45-degree field of view: 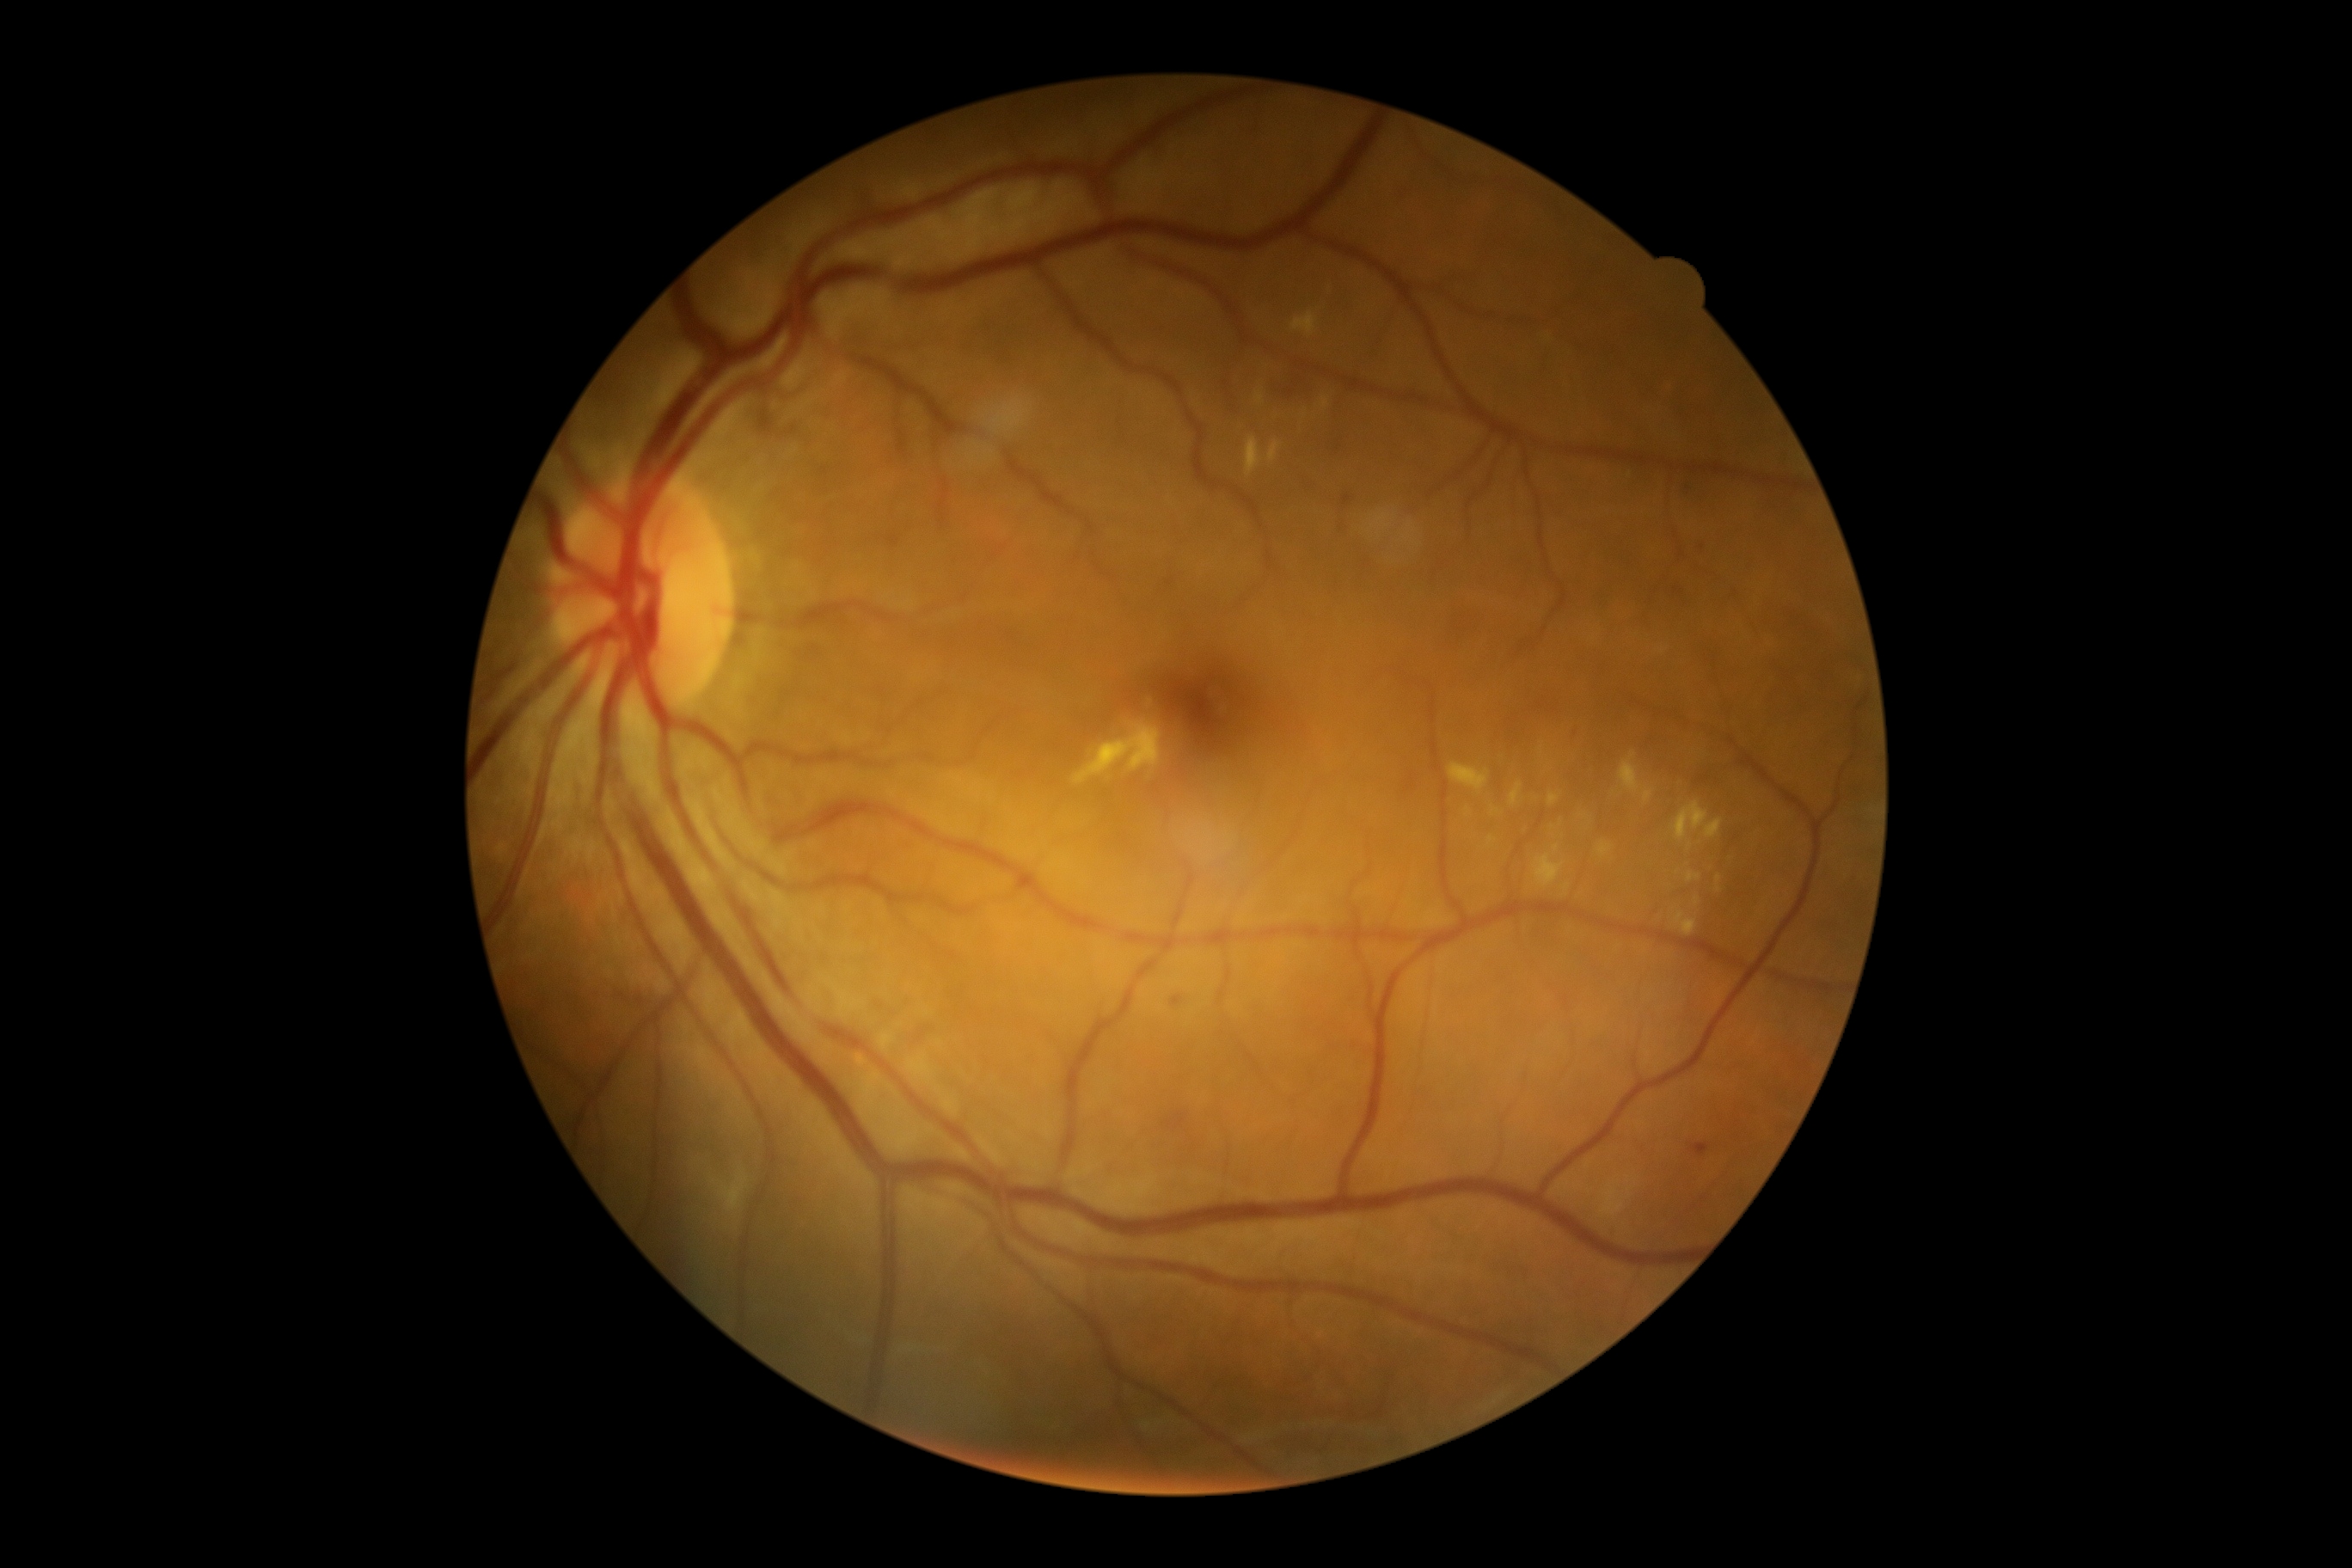

{"partial":true,"dr_grade":2,"lesions":{"ma":[[1682,484,1693,493],[1674,587,1686,597]],"ma_small":[[1702,547]],"he":[[1282,374,1306,400],[1170,995,1185,1008],[637,996,649,1008],[1161,1110,1191,1134],[616,991,630,1003],[1687,1142,1715,1160]],"se":null,"ex":[[1645,790,1653,802],[1598,842,1614,859],[1246,436,1263,477],[1074,723,1163,785],[709,1172,749,1213],[1548,793,1560,807],[1675,912,1696,936],[1534,854,1565,888],[1256,391,1265,405],[1694,897,1700,905]],"ex_small":[[1494,812],[1690,846],[1493,840]]}}